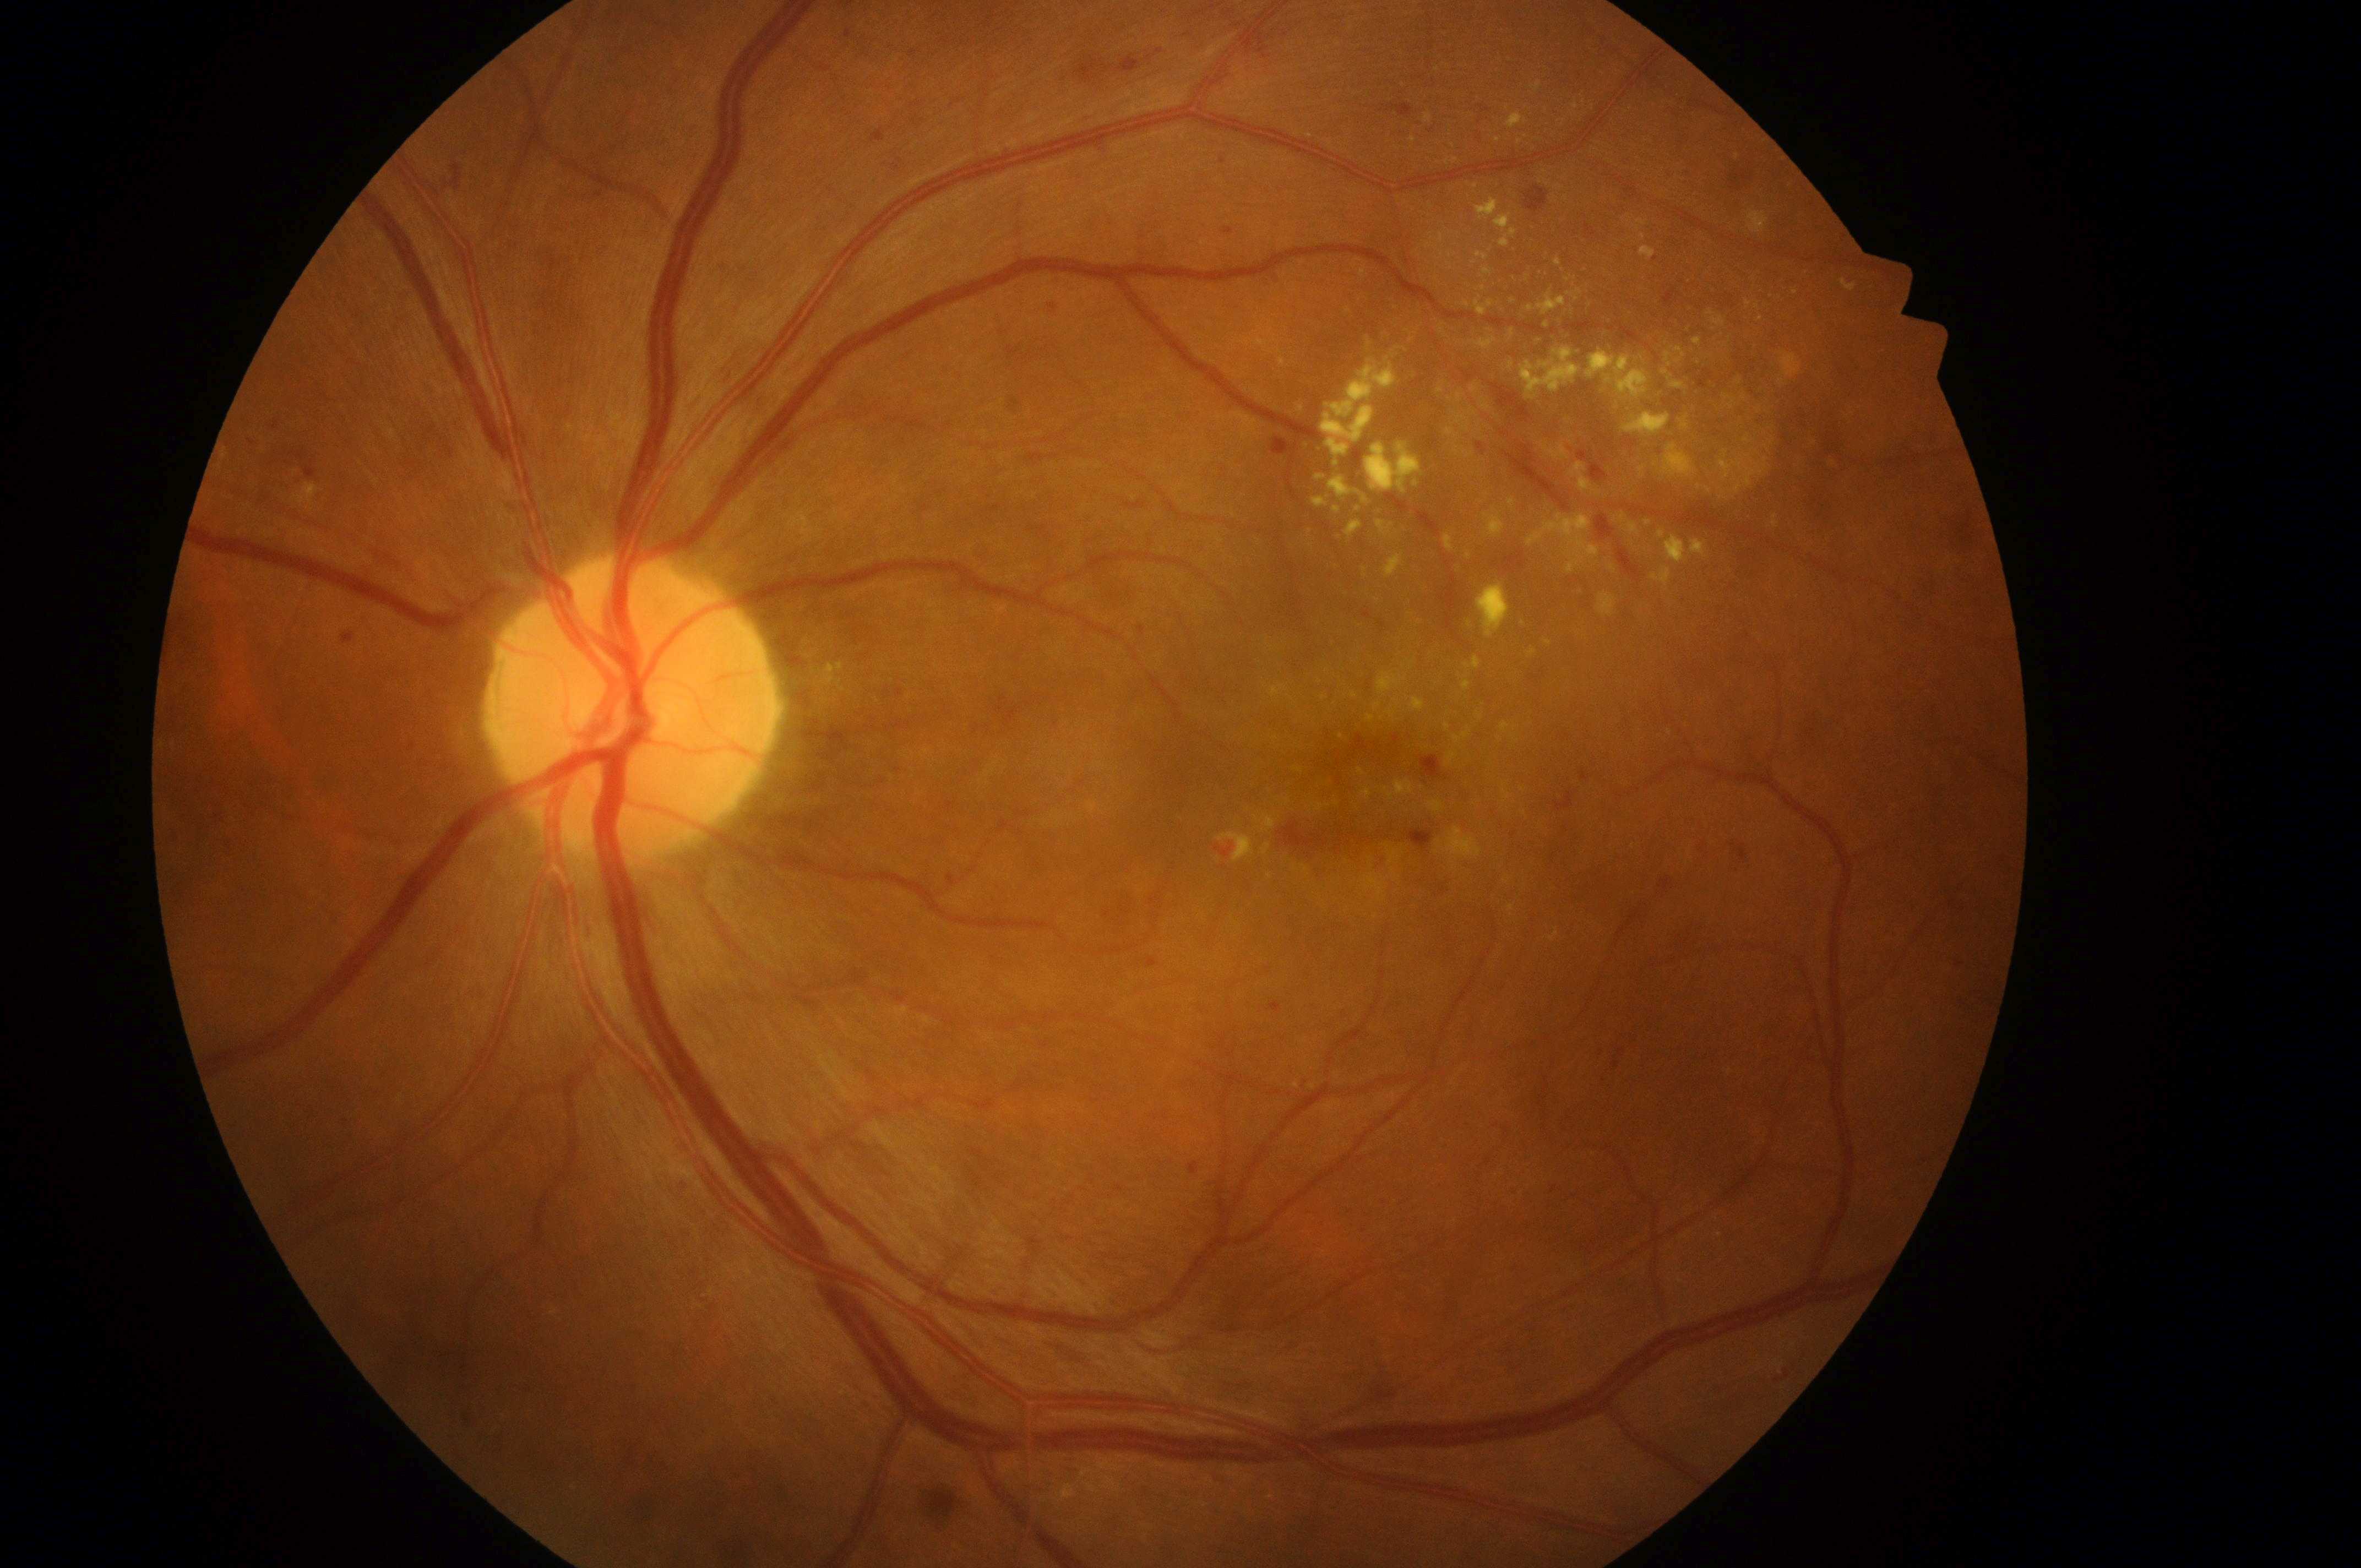 Fovea located at 1332, 804.
Macular edema is high risk (grade 2).
ONH: 618, 715.
Disease class: non-proliferative diabetic retinopathy.
The image shows the OS.
Retinopathy is moderate non-proliferative diabetic retinopathy (grade 2).